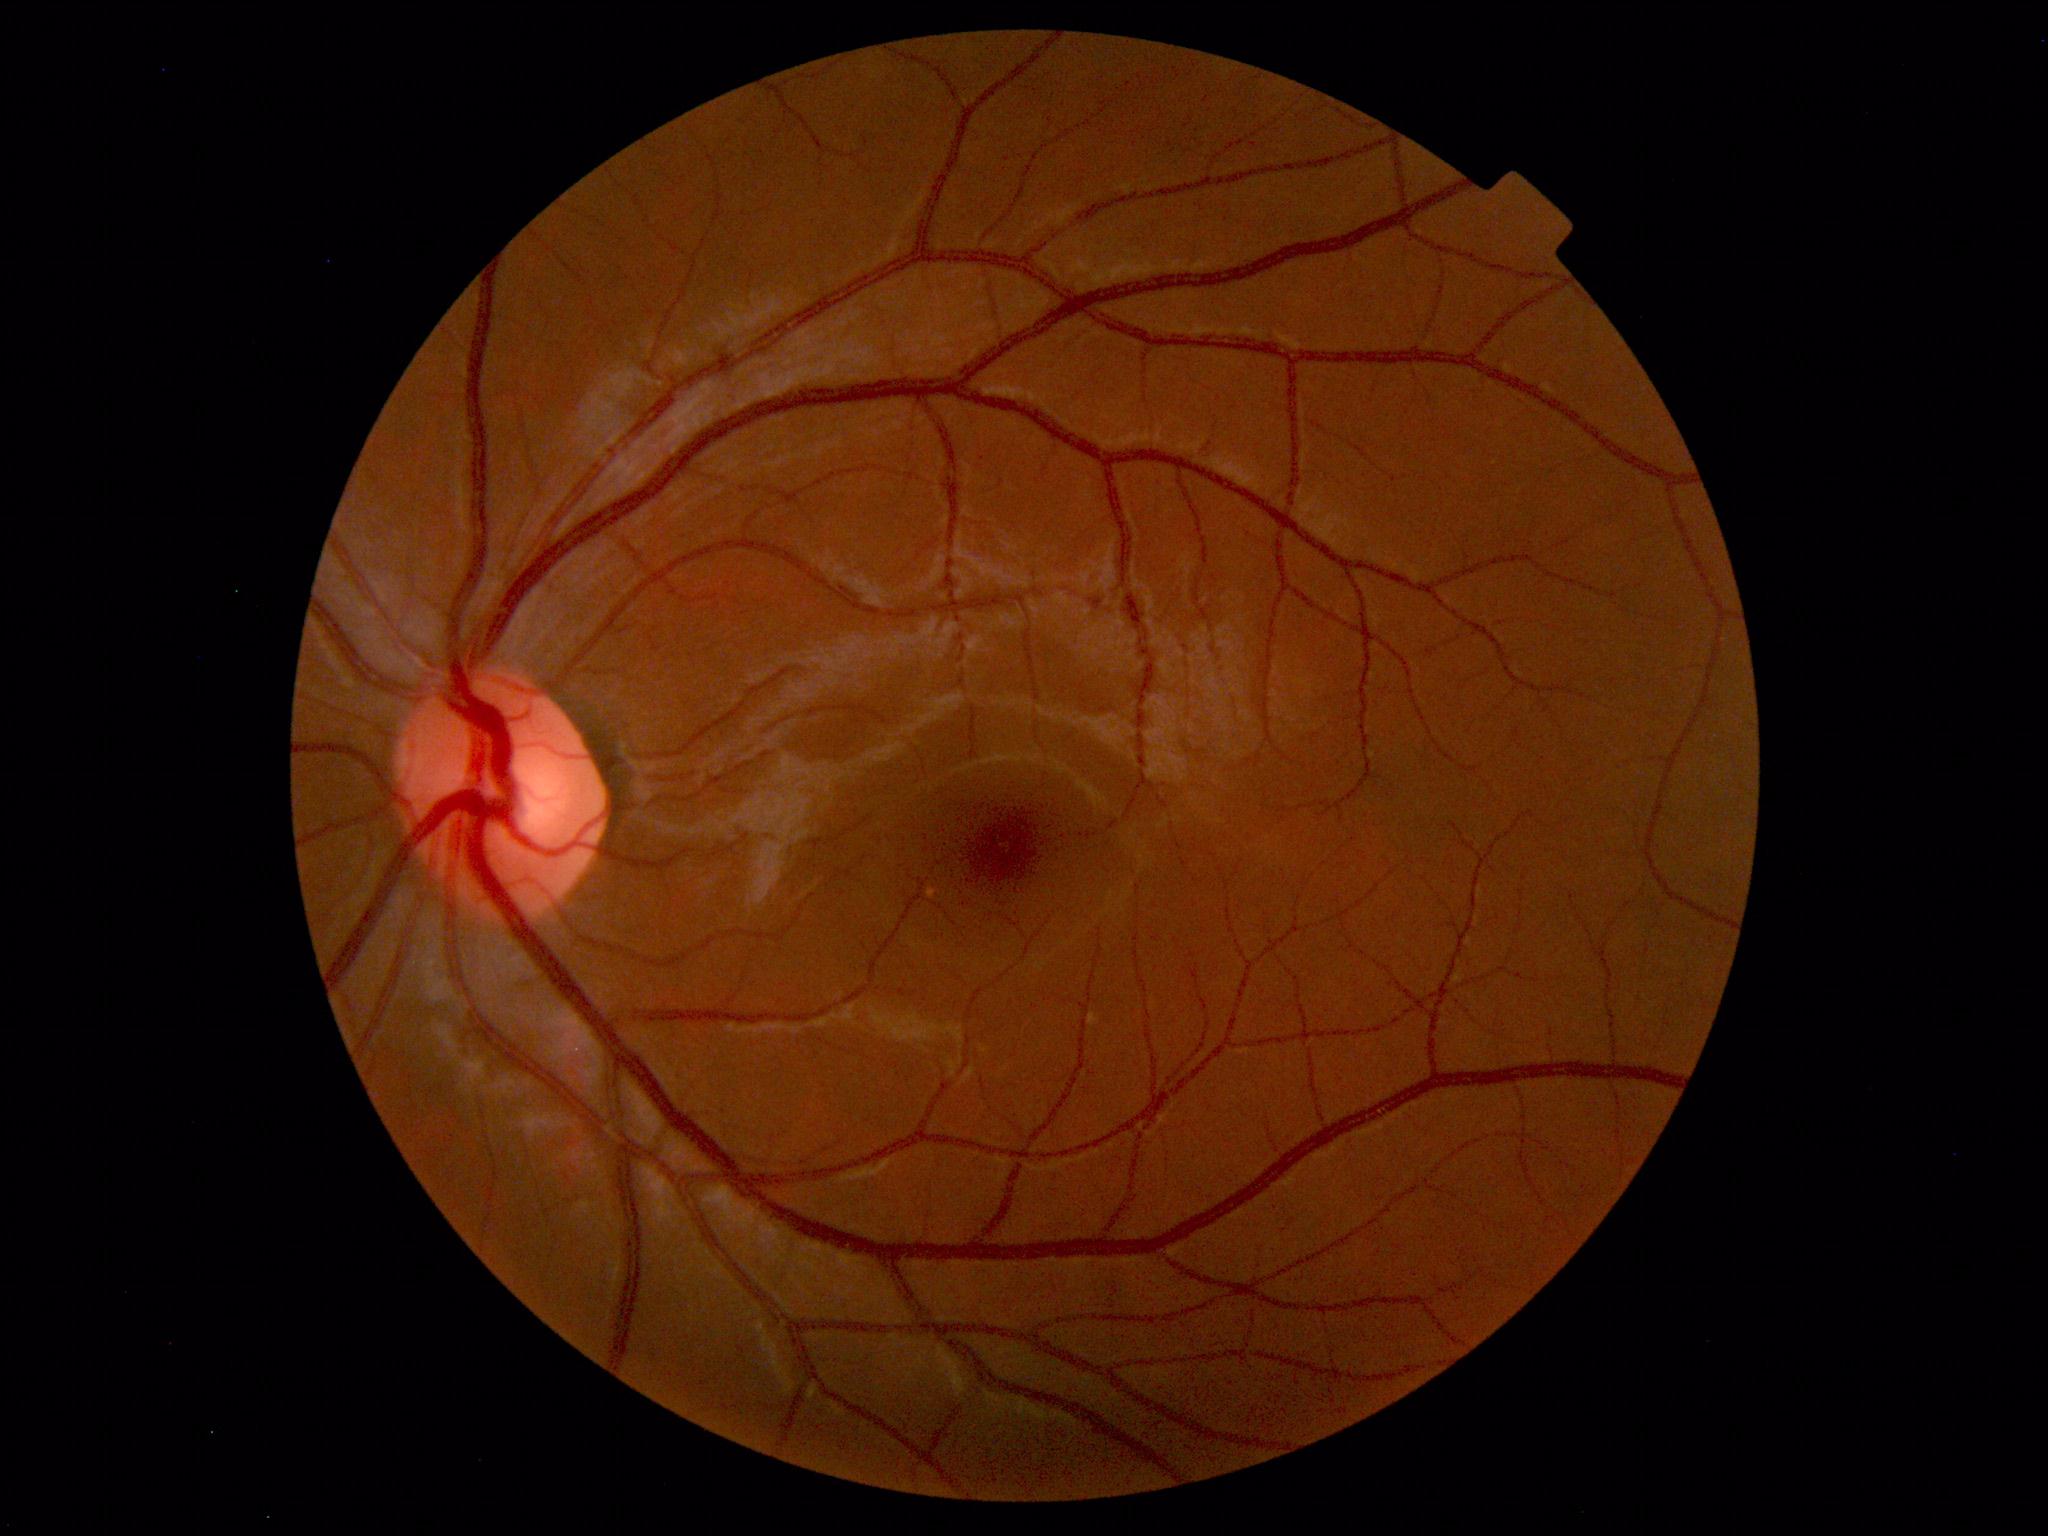
No abnormal findings on fundus examination.